45° field of view. 2352 by 1568 pixels. Color fundus photograph: 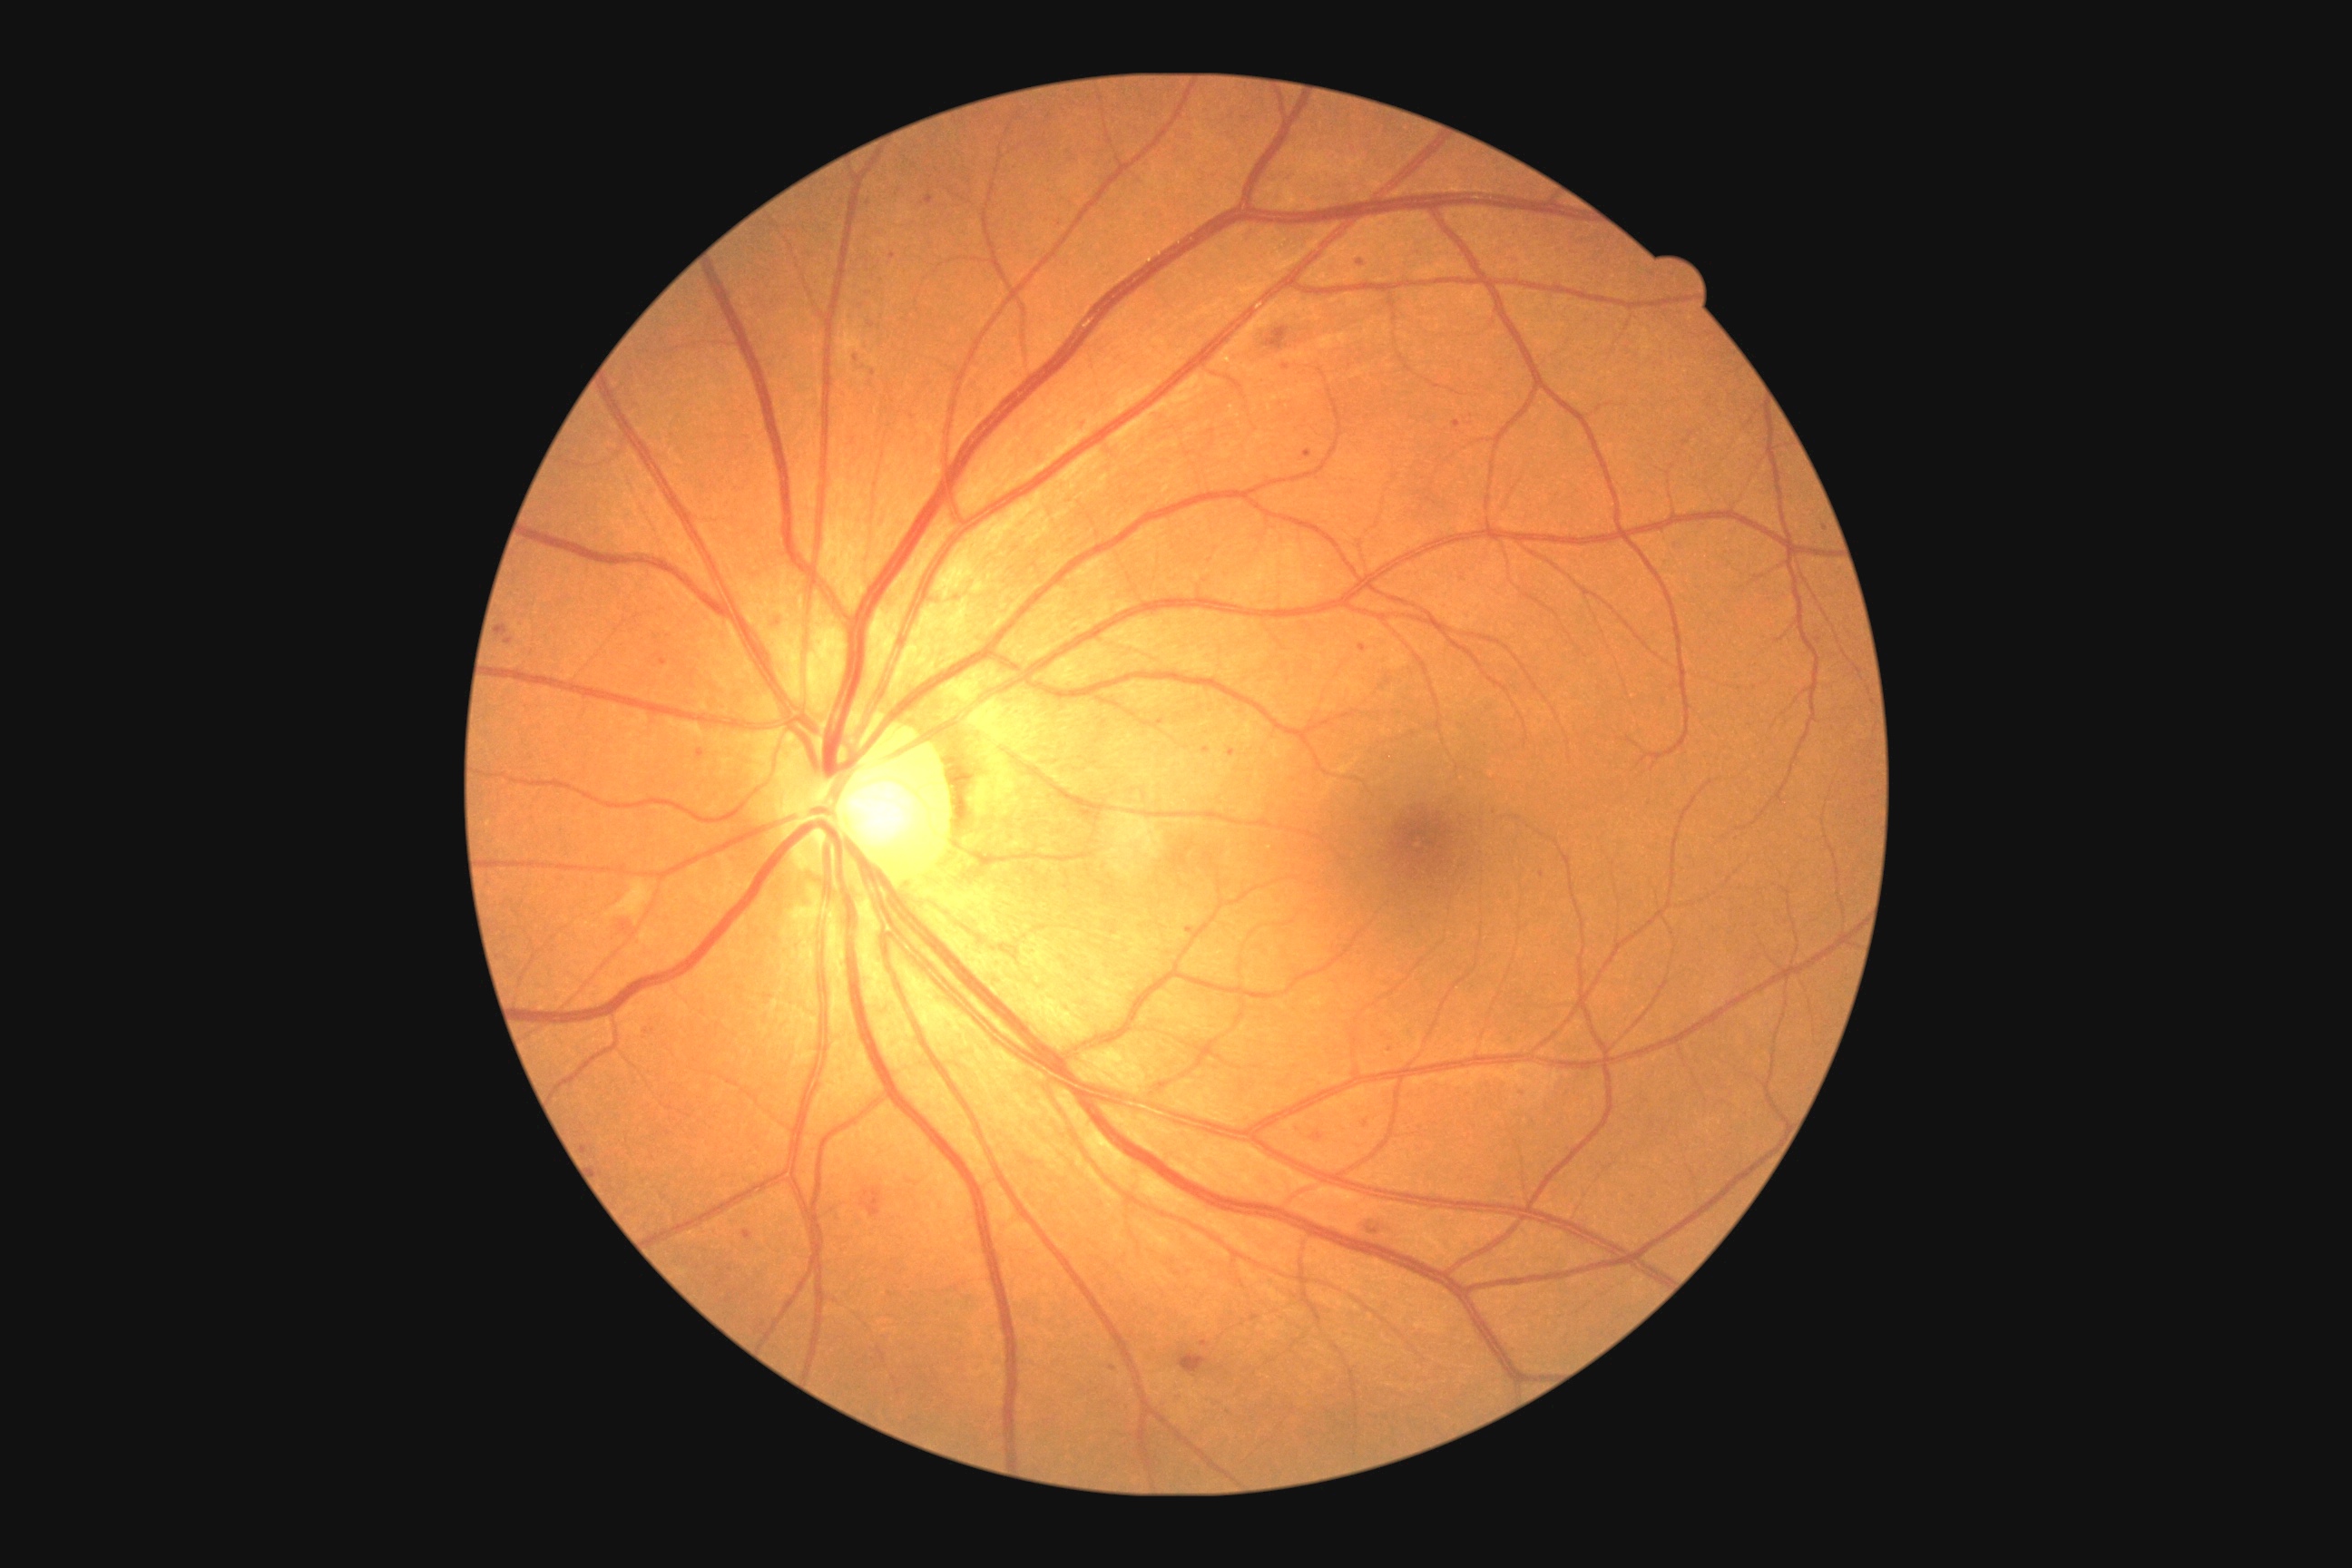

Diabetic retinopathy (DR) is grade 2 (moderate NPDR).
Microaneurysms (MAs) include bbox(1465, 614, 1473, 618) | bbox(504, 638, 514, 645) | bbox(925, 197, 934, 204) | bbox(496, 623, 509, 636) | bbox(1202, 745, 1210, 750) | bbox(1077, 424, 1086, 433) | bbox(769, 614, 779, 629) | bbox(696, 750, 705, 760) | bbox(1358, 645, 1367, 652) | bbox(643, 1026, 652, 1039).
Small MAs near (x=856, y=359) | (x=1542, y=874) | (x=1825, y=530) | (x=663, y=662) | (x=873, y=326) | (x=1205, y=1343) | (x=1285, y=368).